Modified Davis classification. 45° FOV. Posterior pole color fundus photograph: 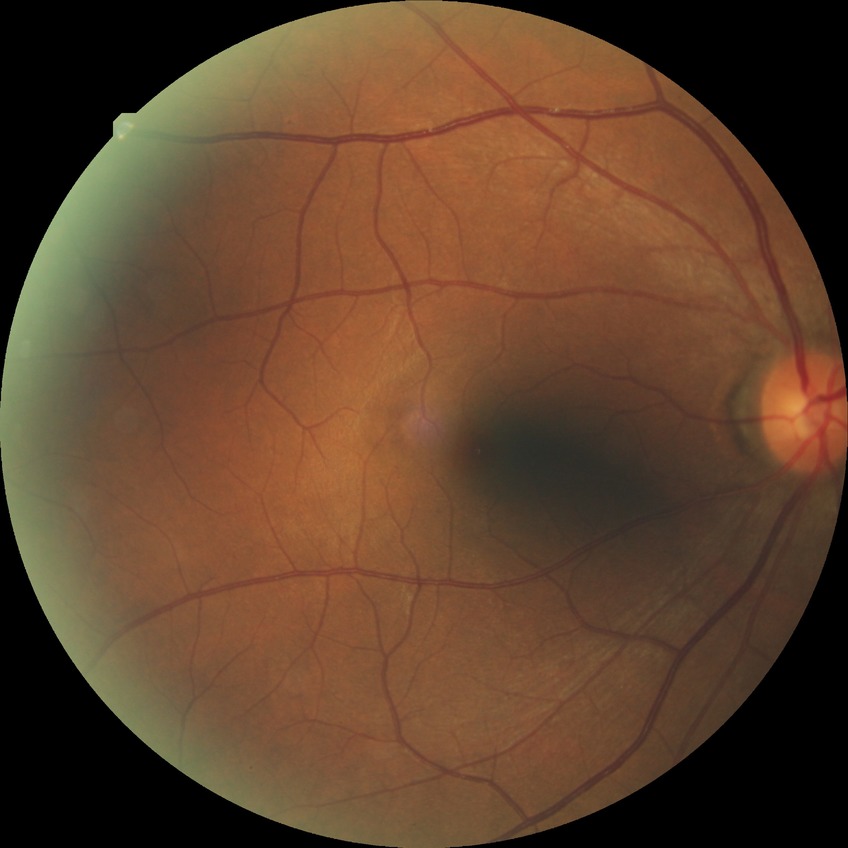 Diabetic retinopathy severity is simple diabetic retinopathy.